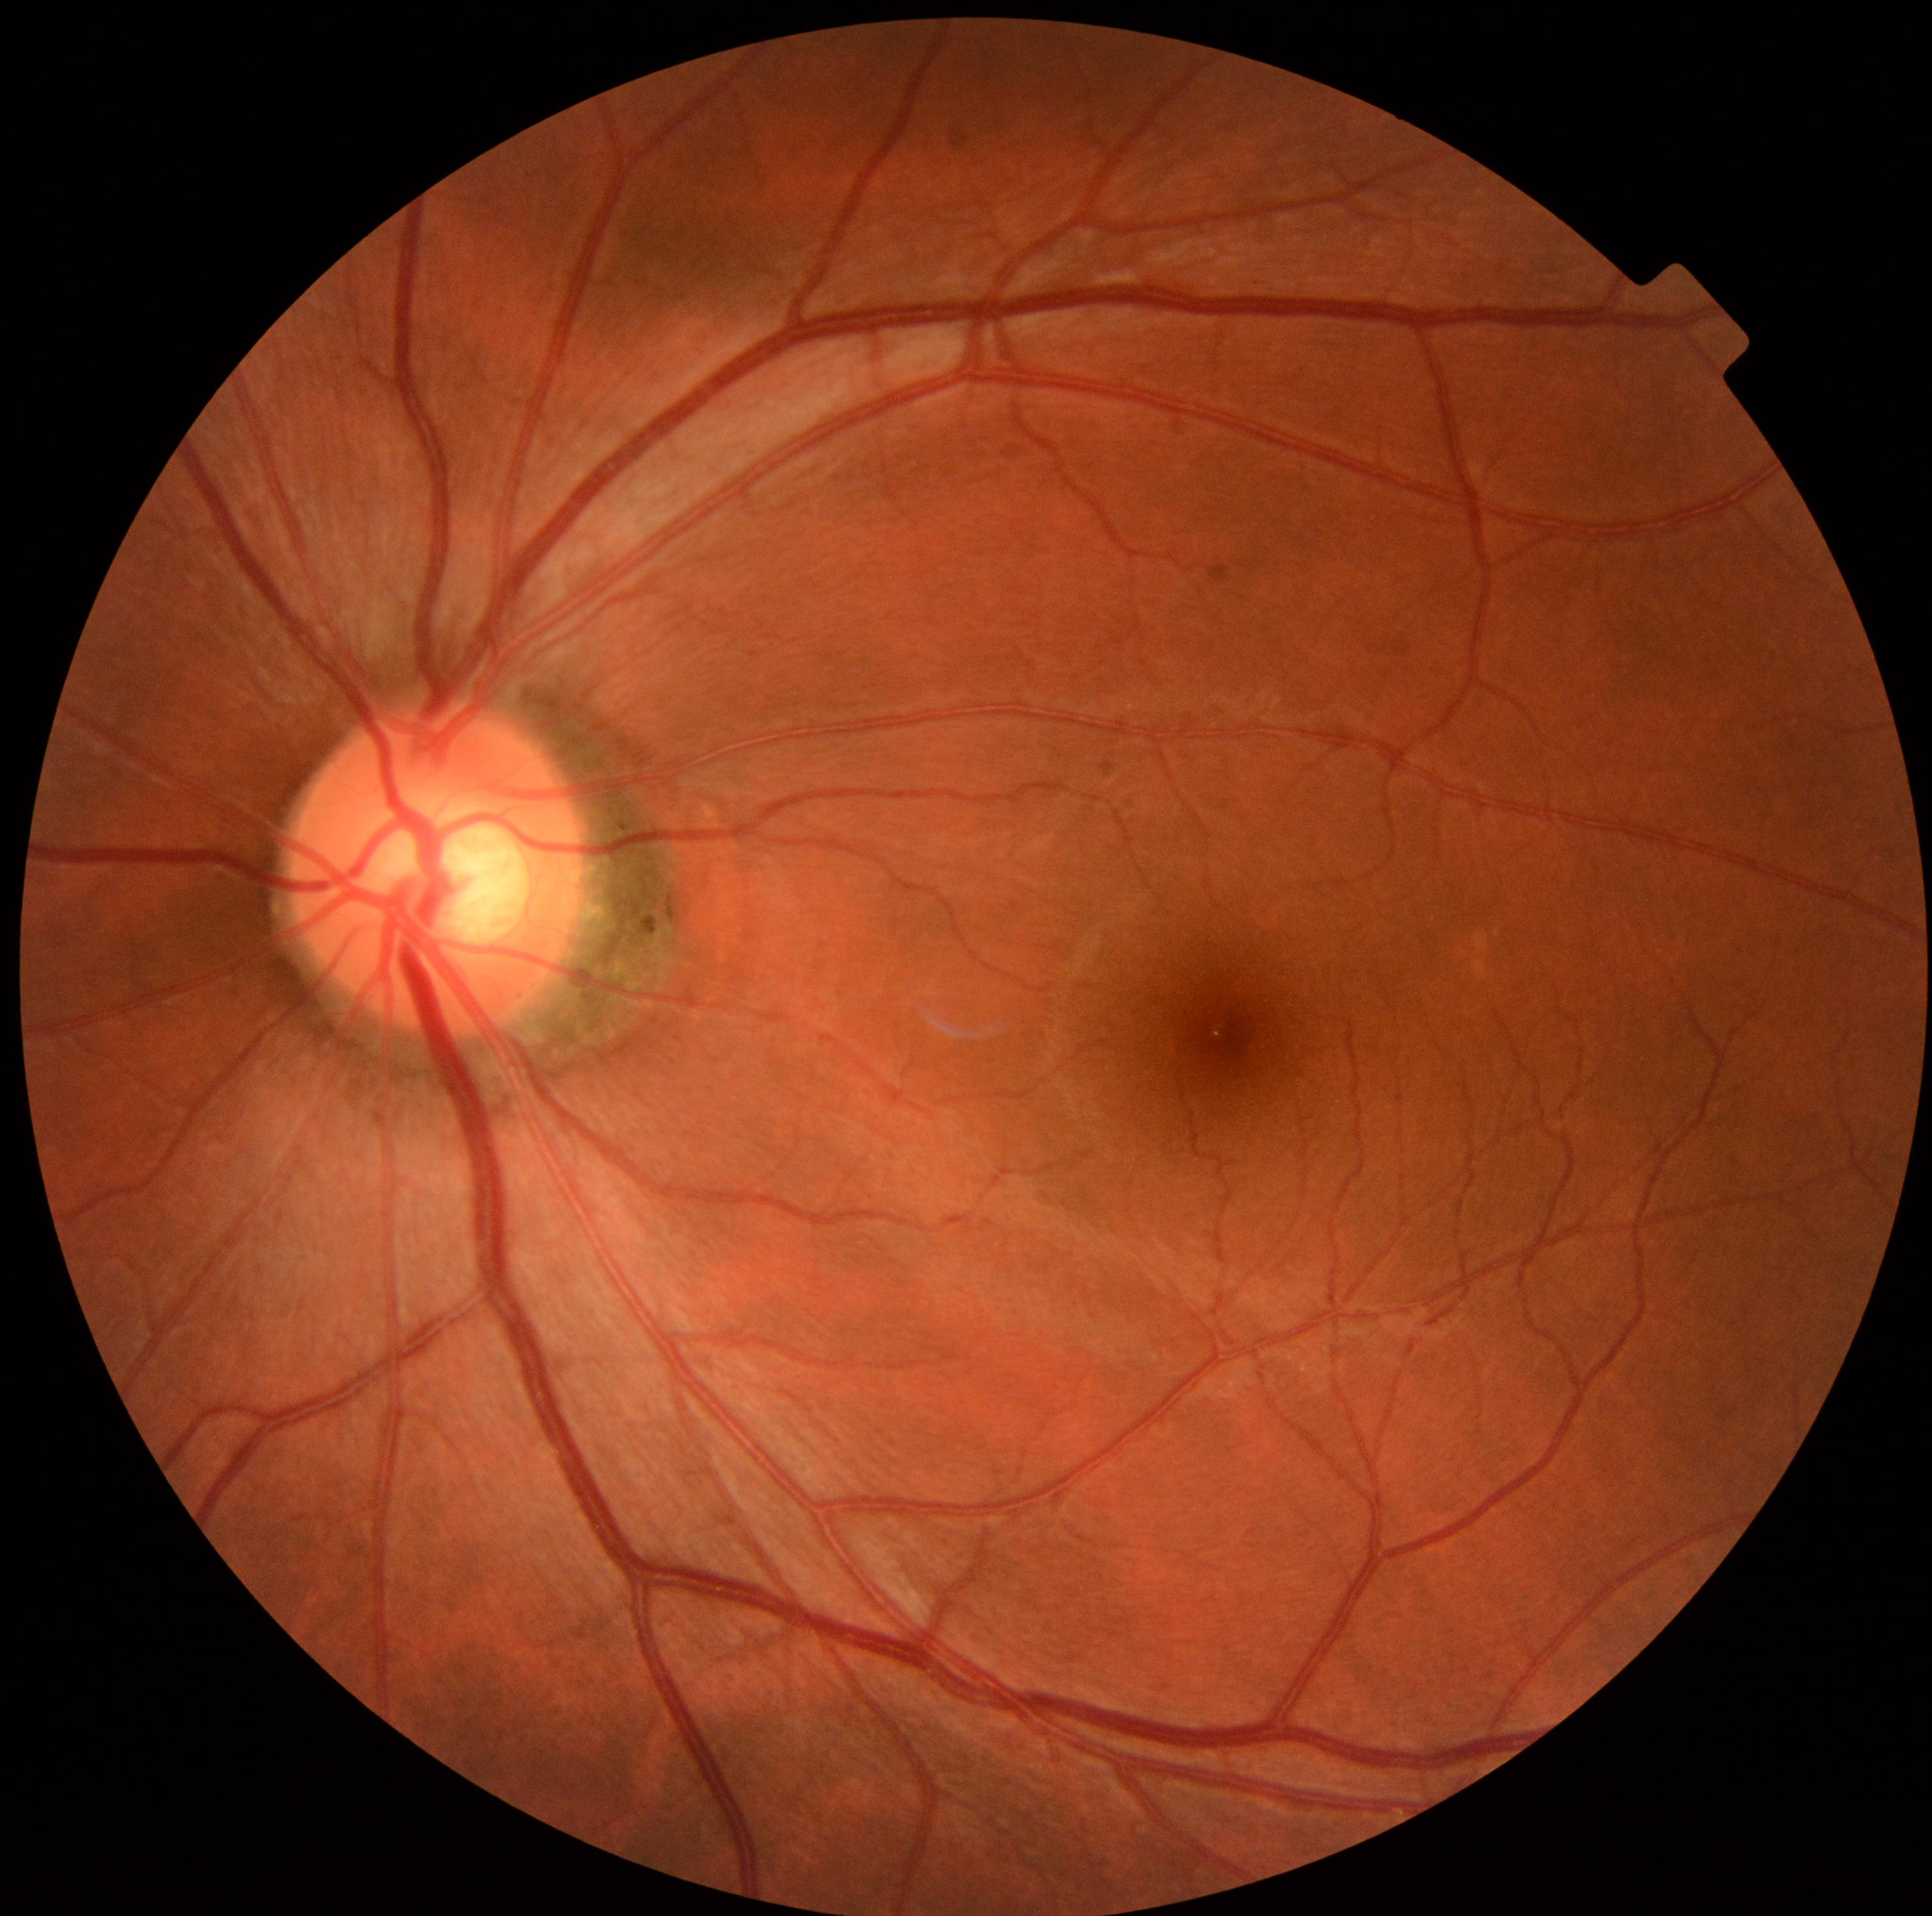
No diabetic retinal disease findings.
DR stage: grade 0 (no apparent retinopathy).